Color fundus image, modified Davis classification, 848x848px.
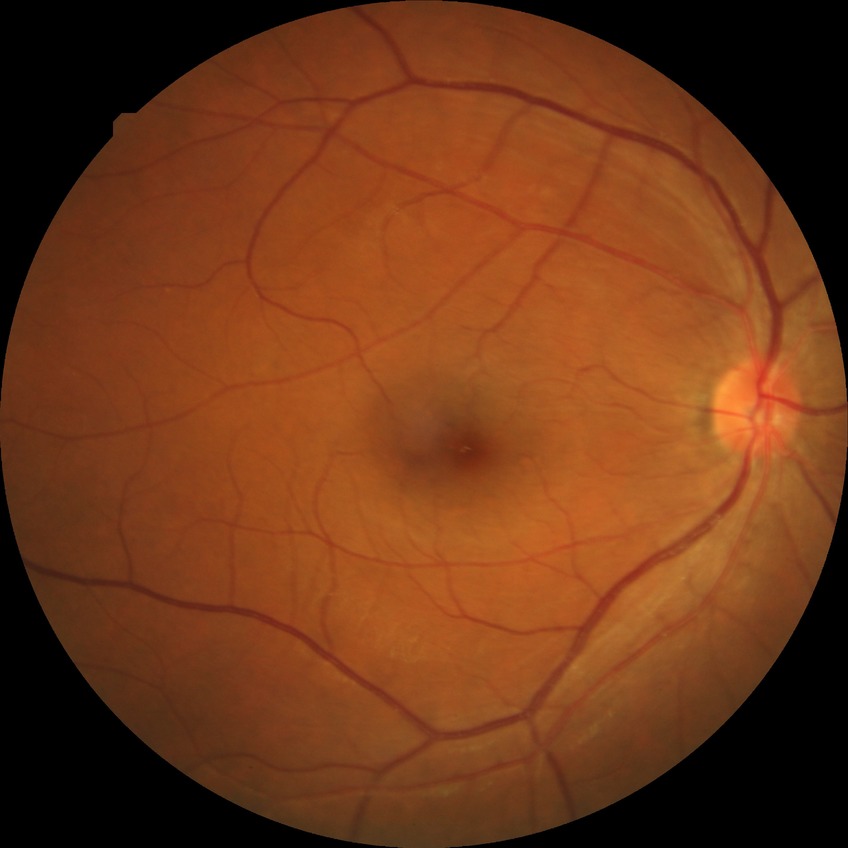

Diabetic retinopathy (DR) is no diabetic retinopathy (NDR).